Color fundus photograph · 45° field of view · 2352x1568.
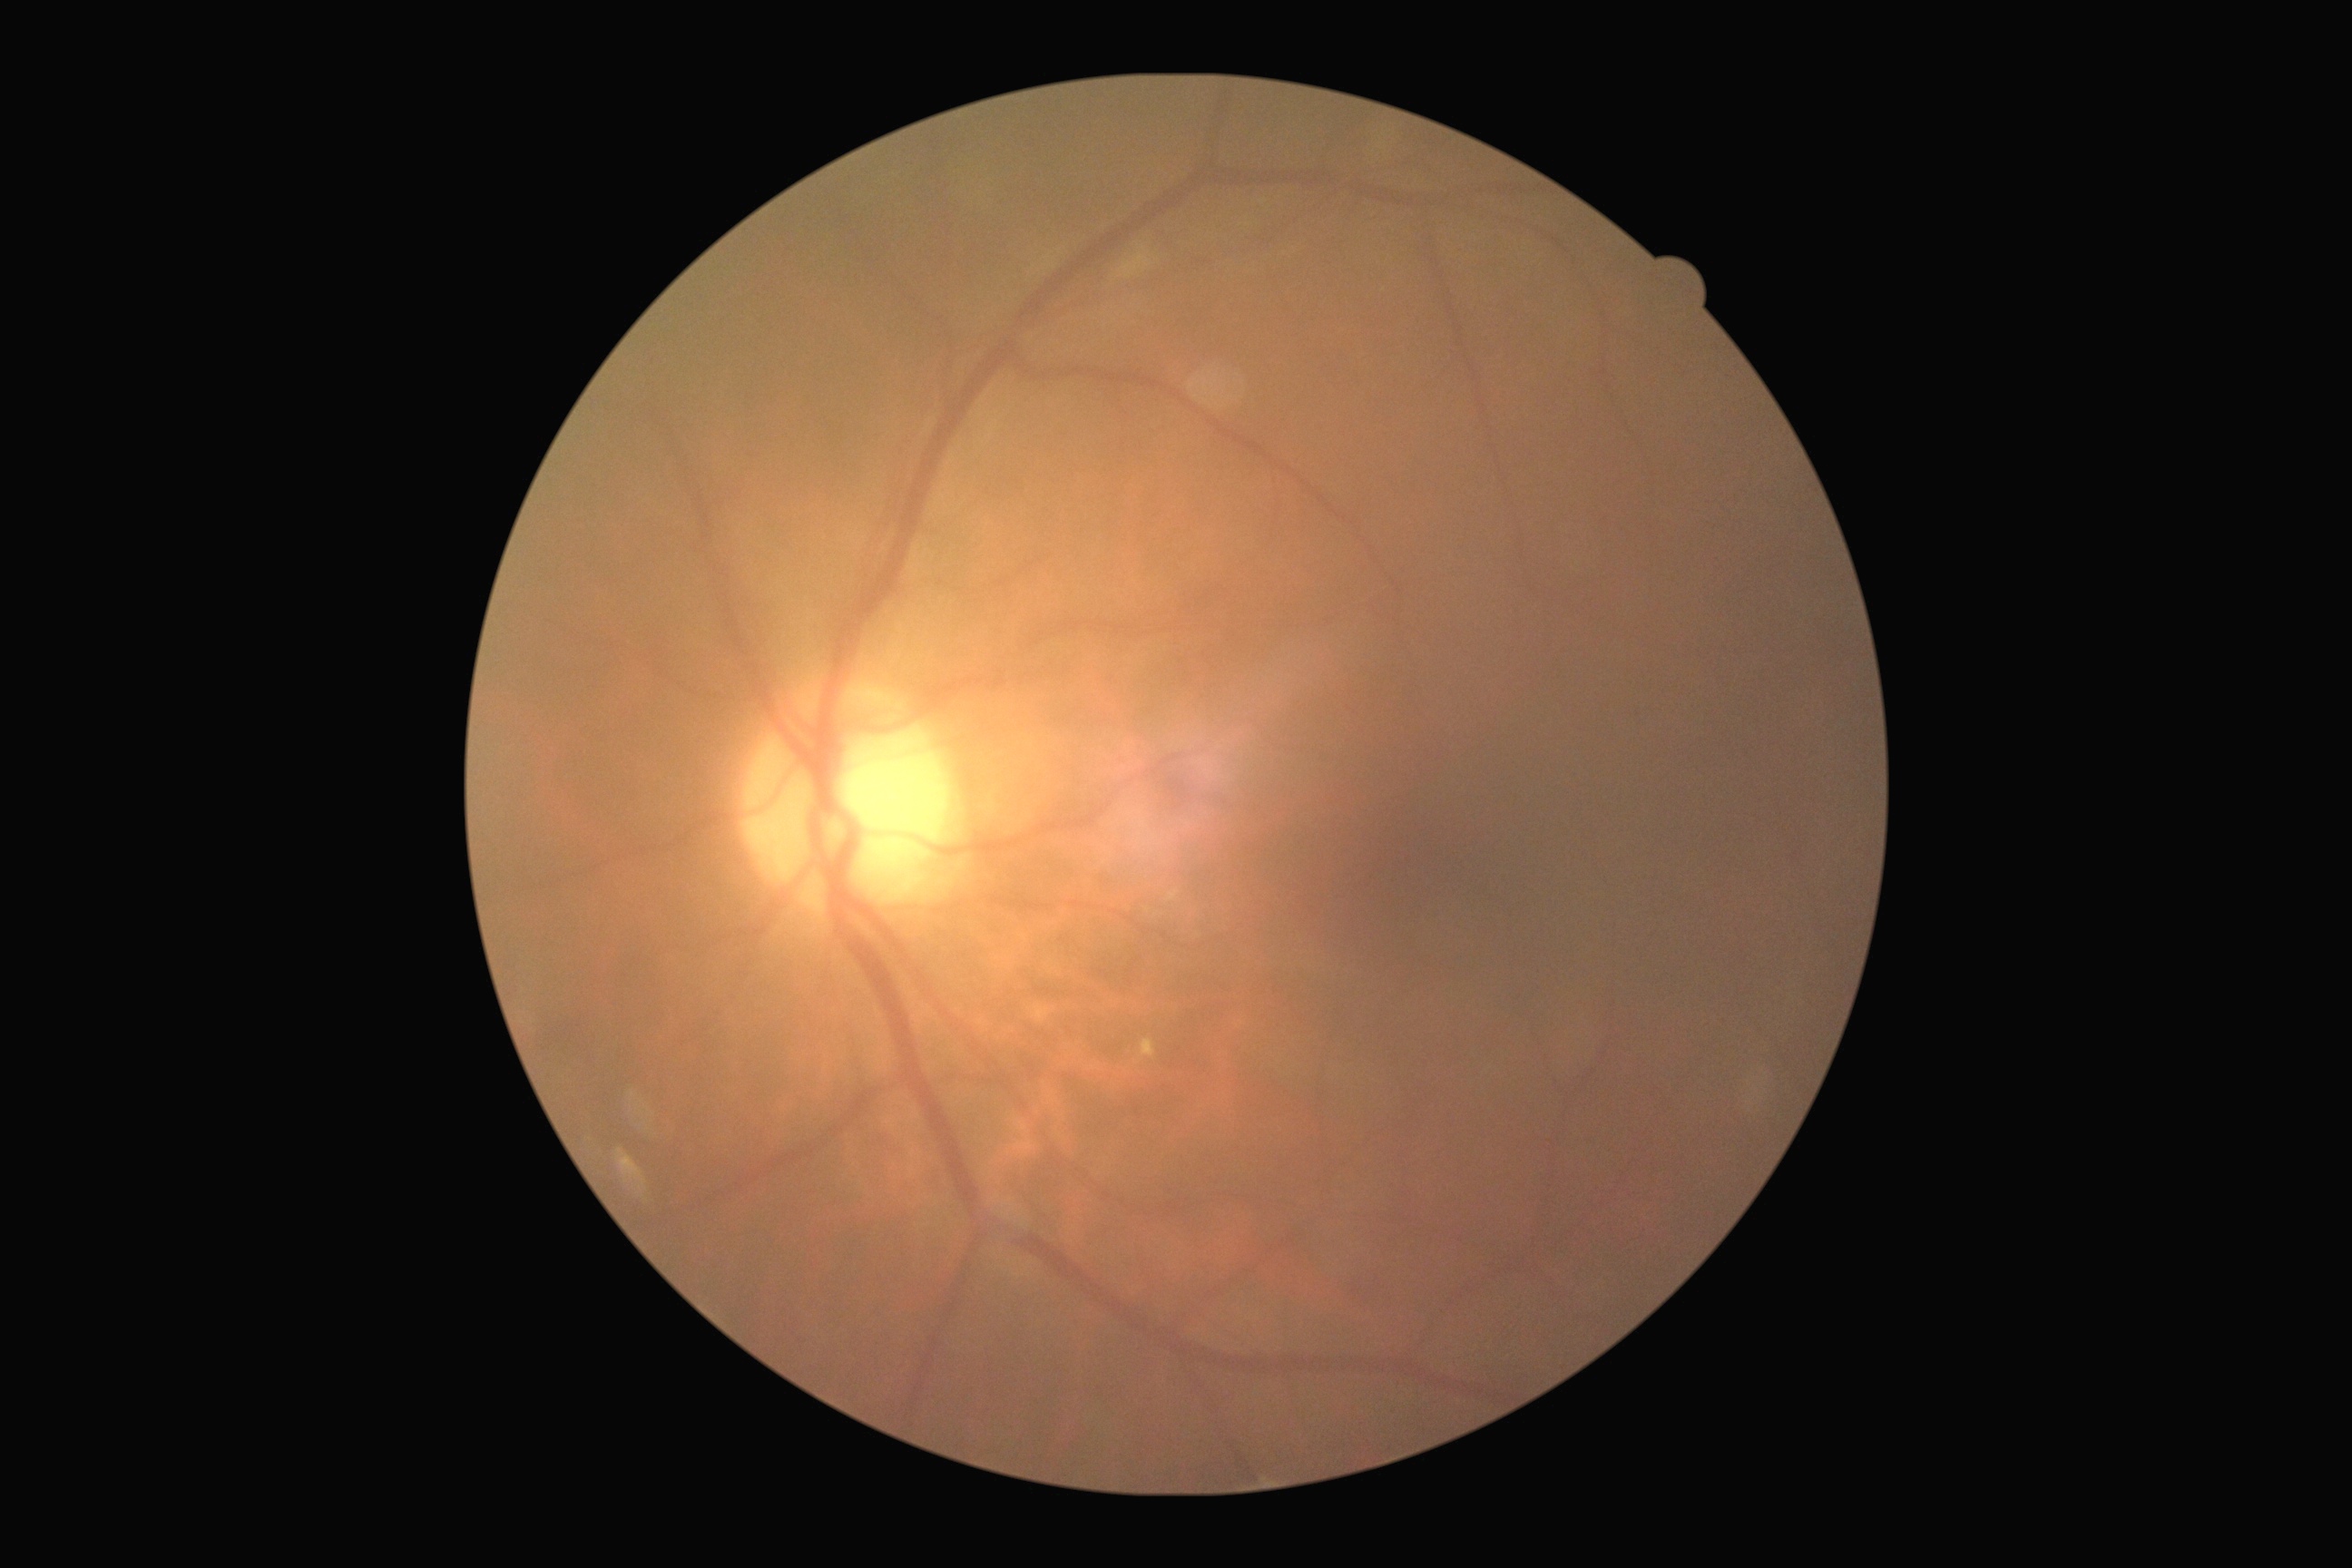
Disease class: non-proliferative diabetic retinopathy. Retinopathy grade is 2/4.